Infant wide-field fundus photograph. 1240 by 1240 pixels
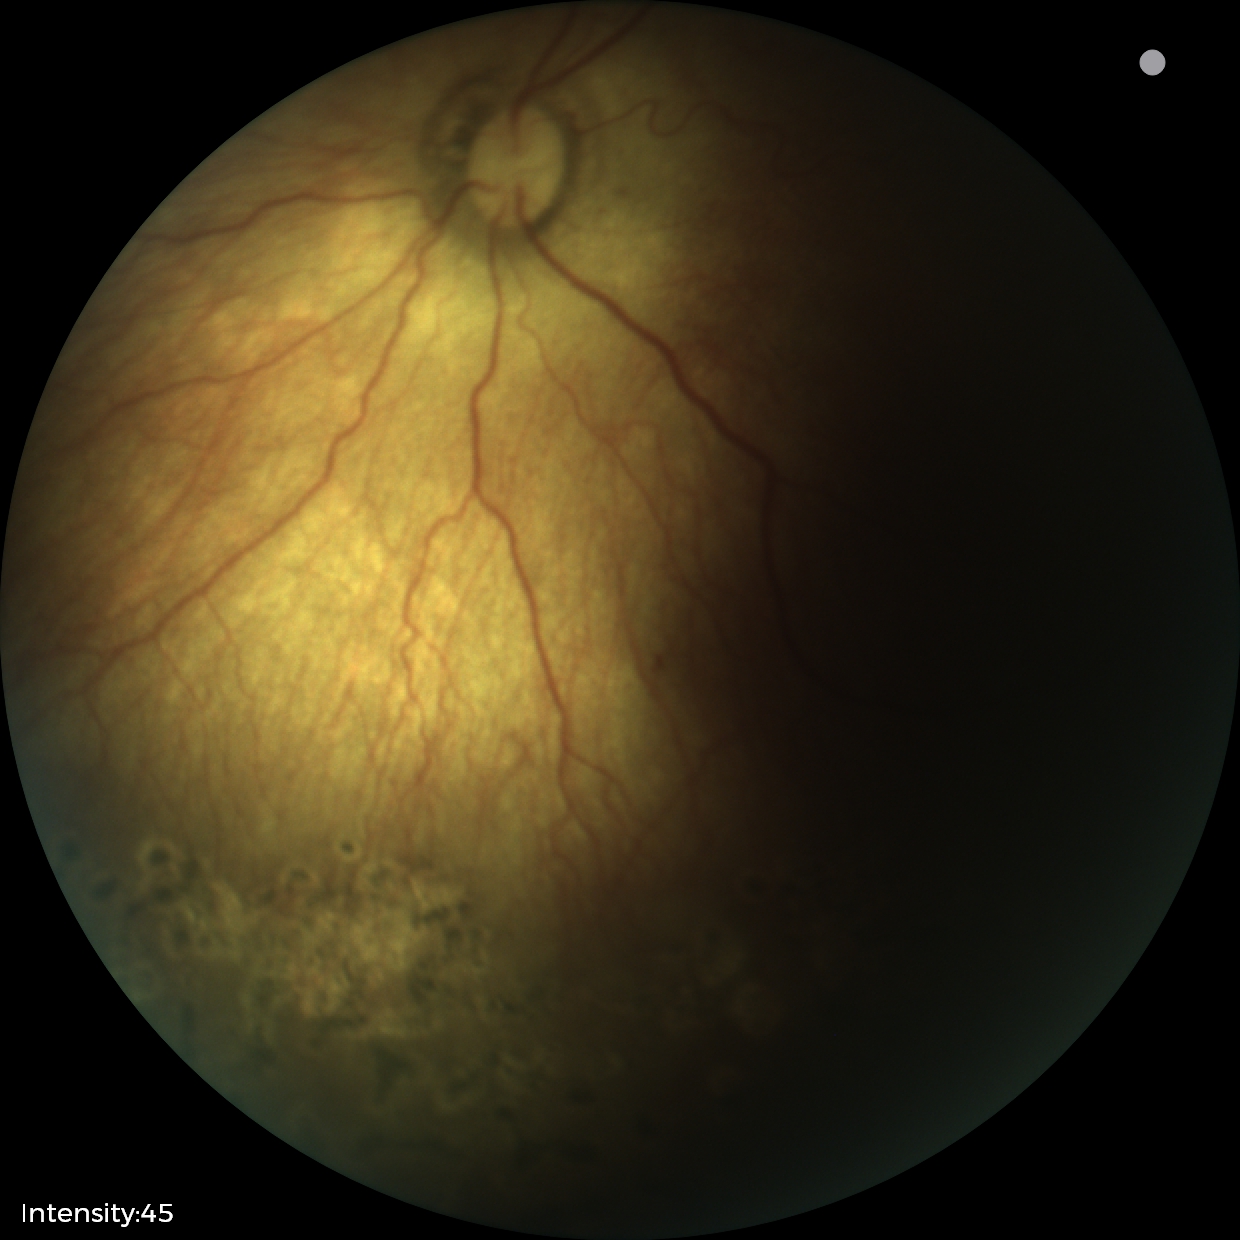

Screening examination consistent with status post retinopathy of prematurity.